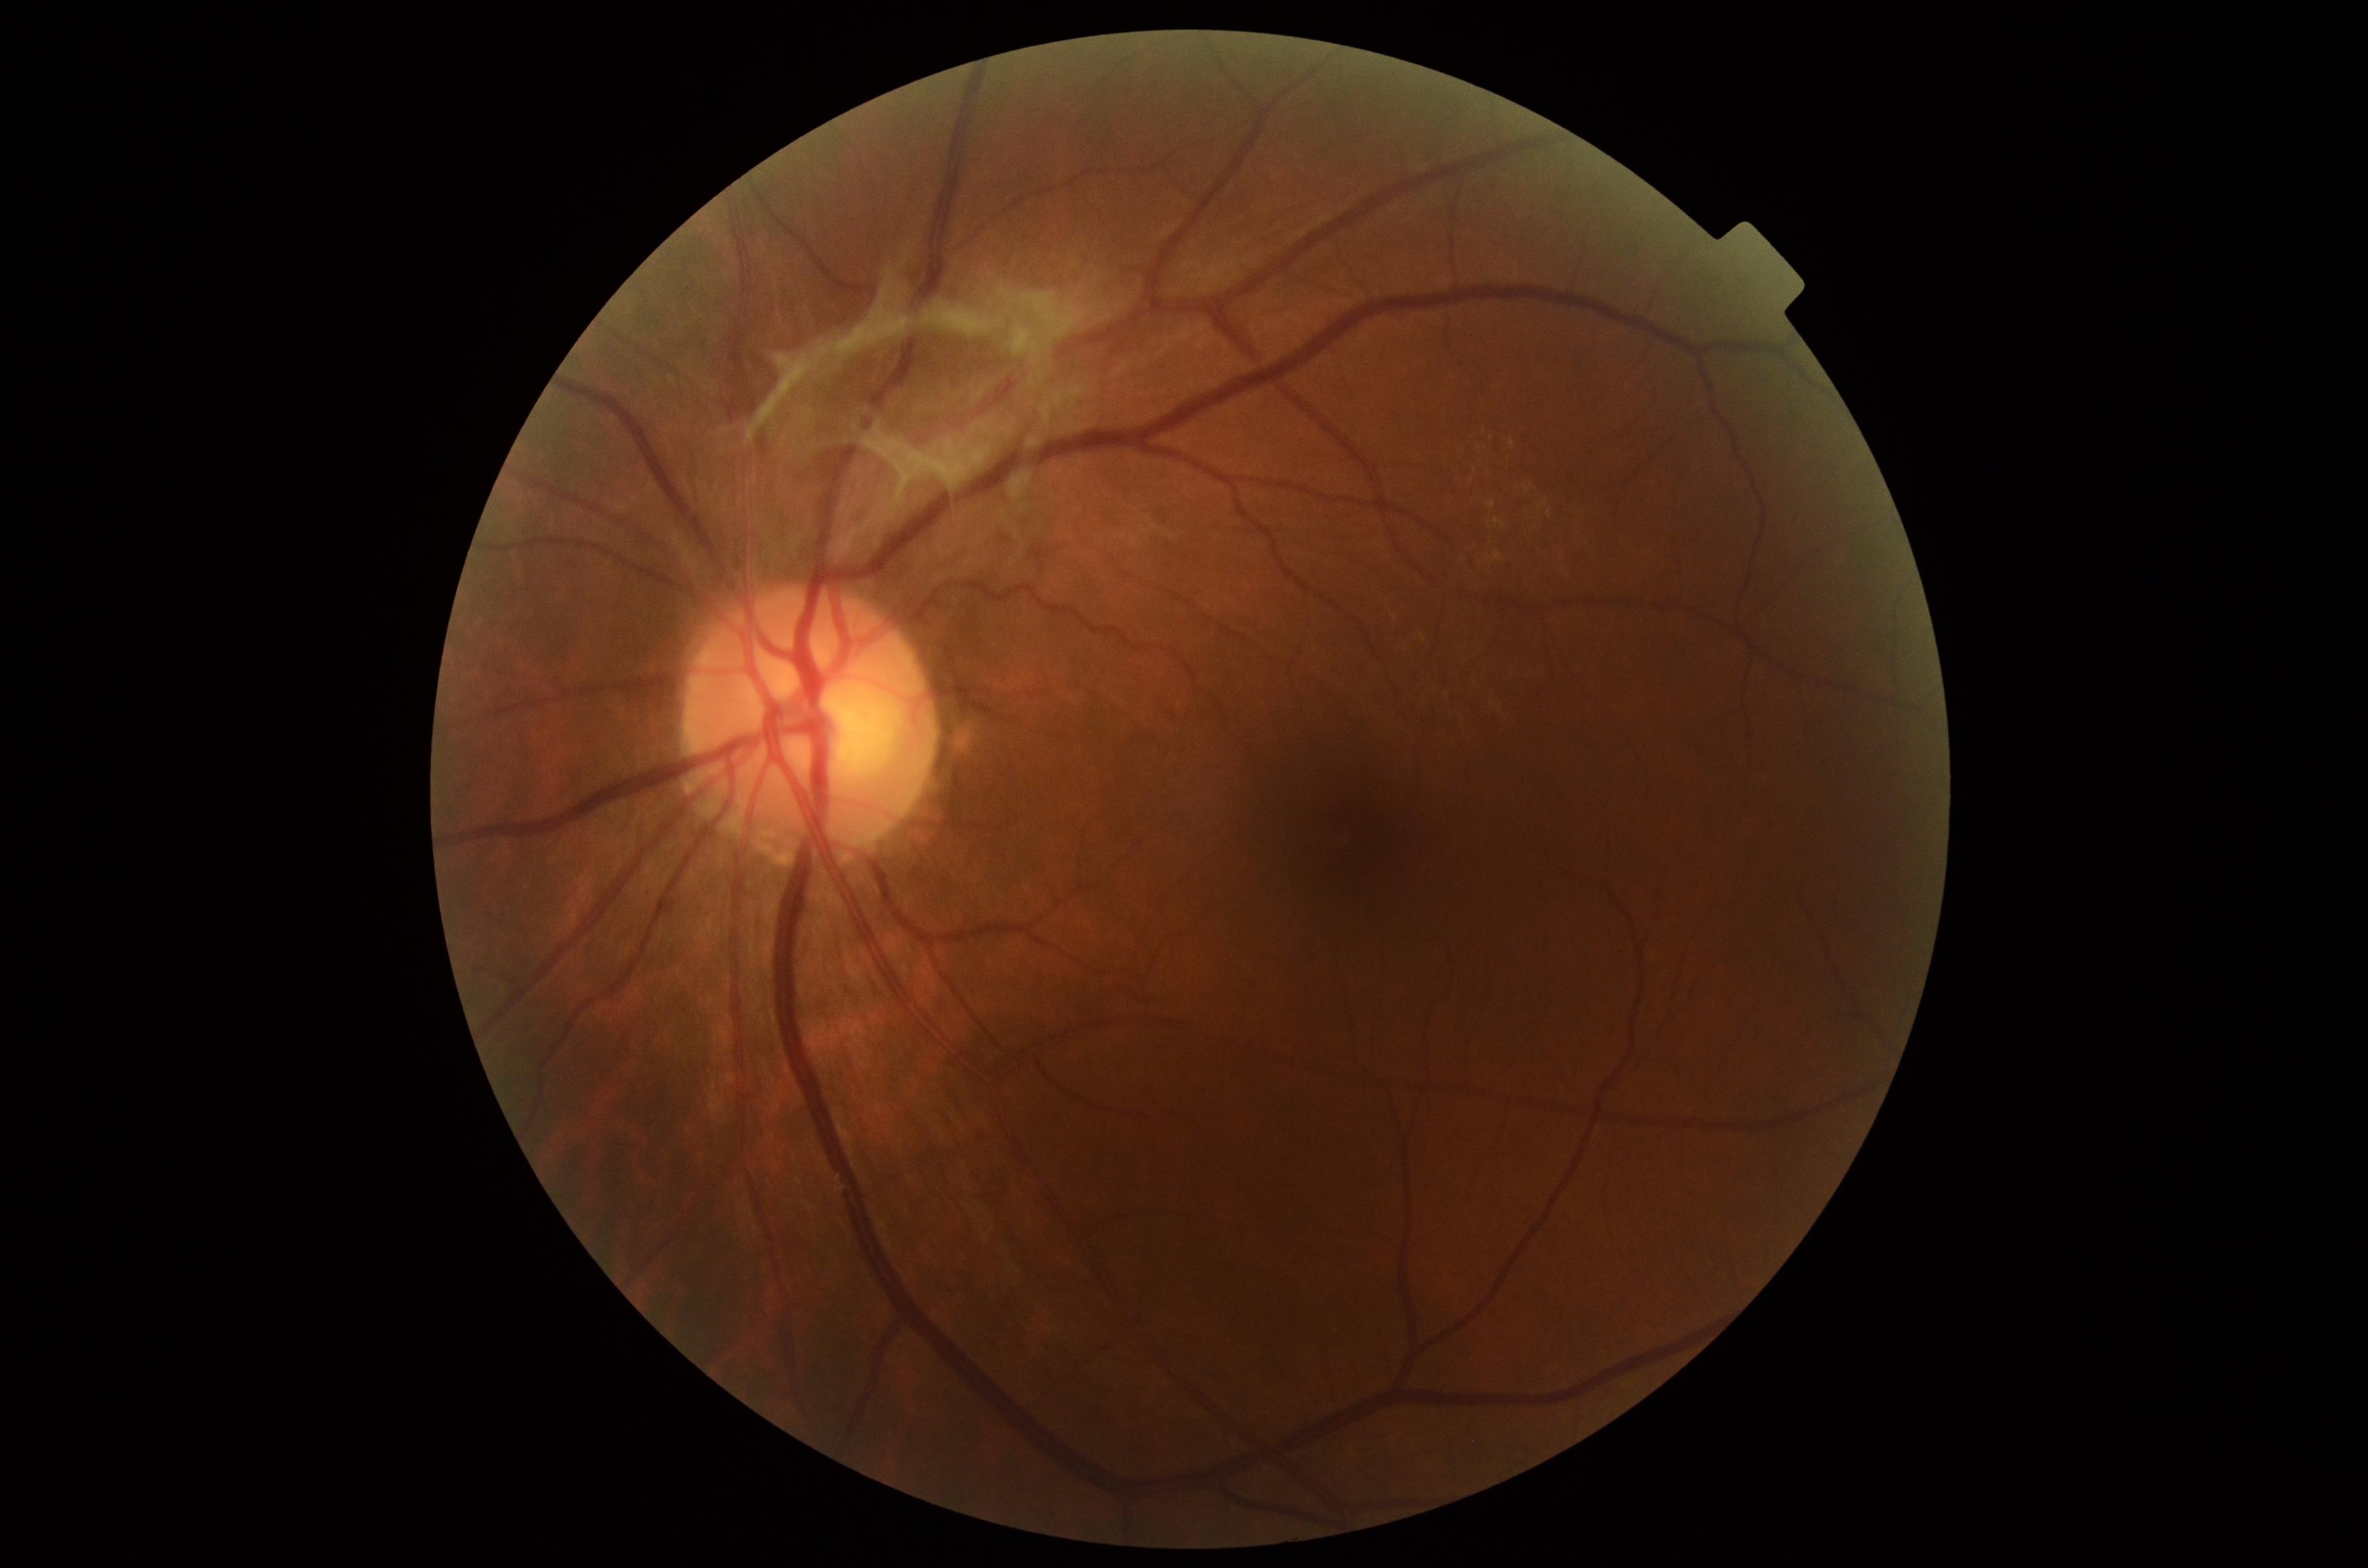
DR class: proliferative diabetic retinopathy; diabetic retinopathy (DR): PDR (grade 4).